FOV: 45 degrees · 1932 by 1932 pixels · fundus photo
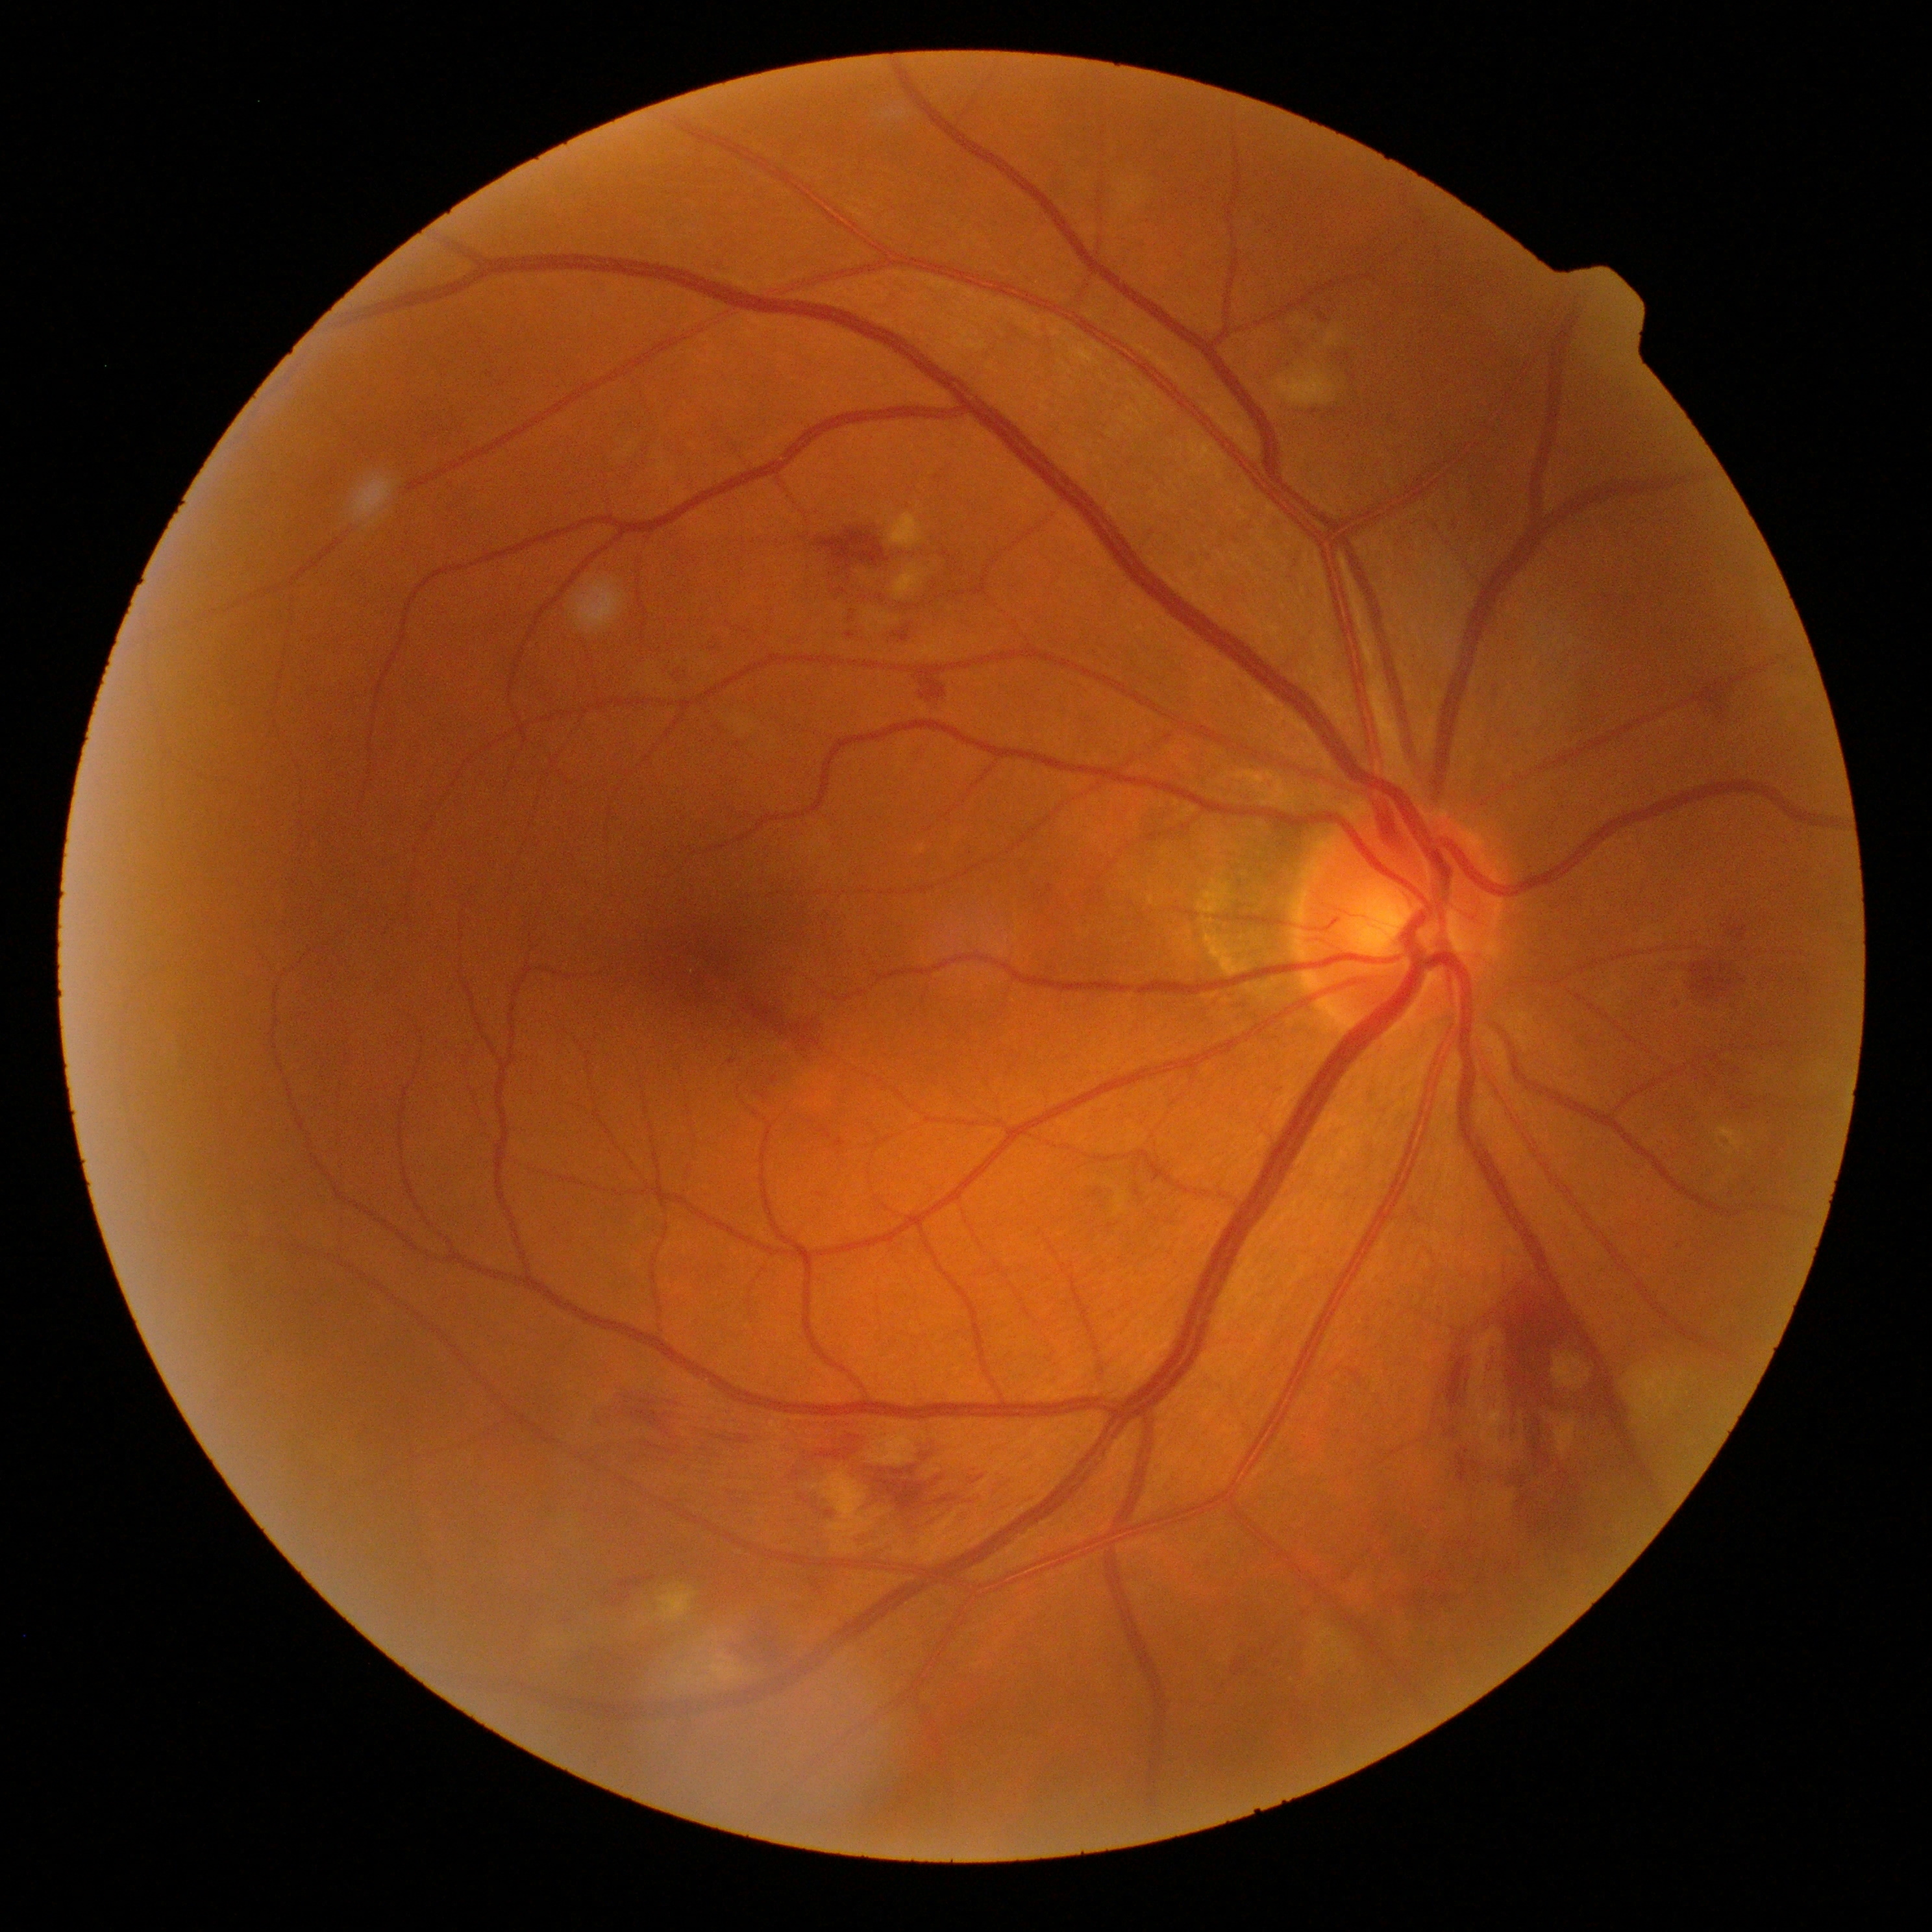

DR stage: 2/4.